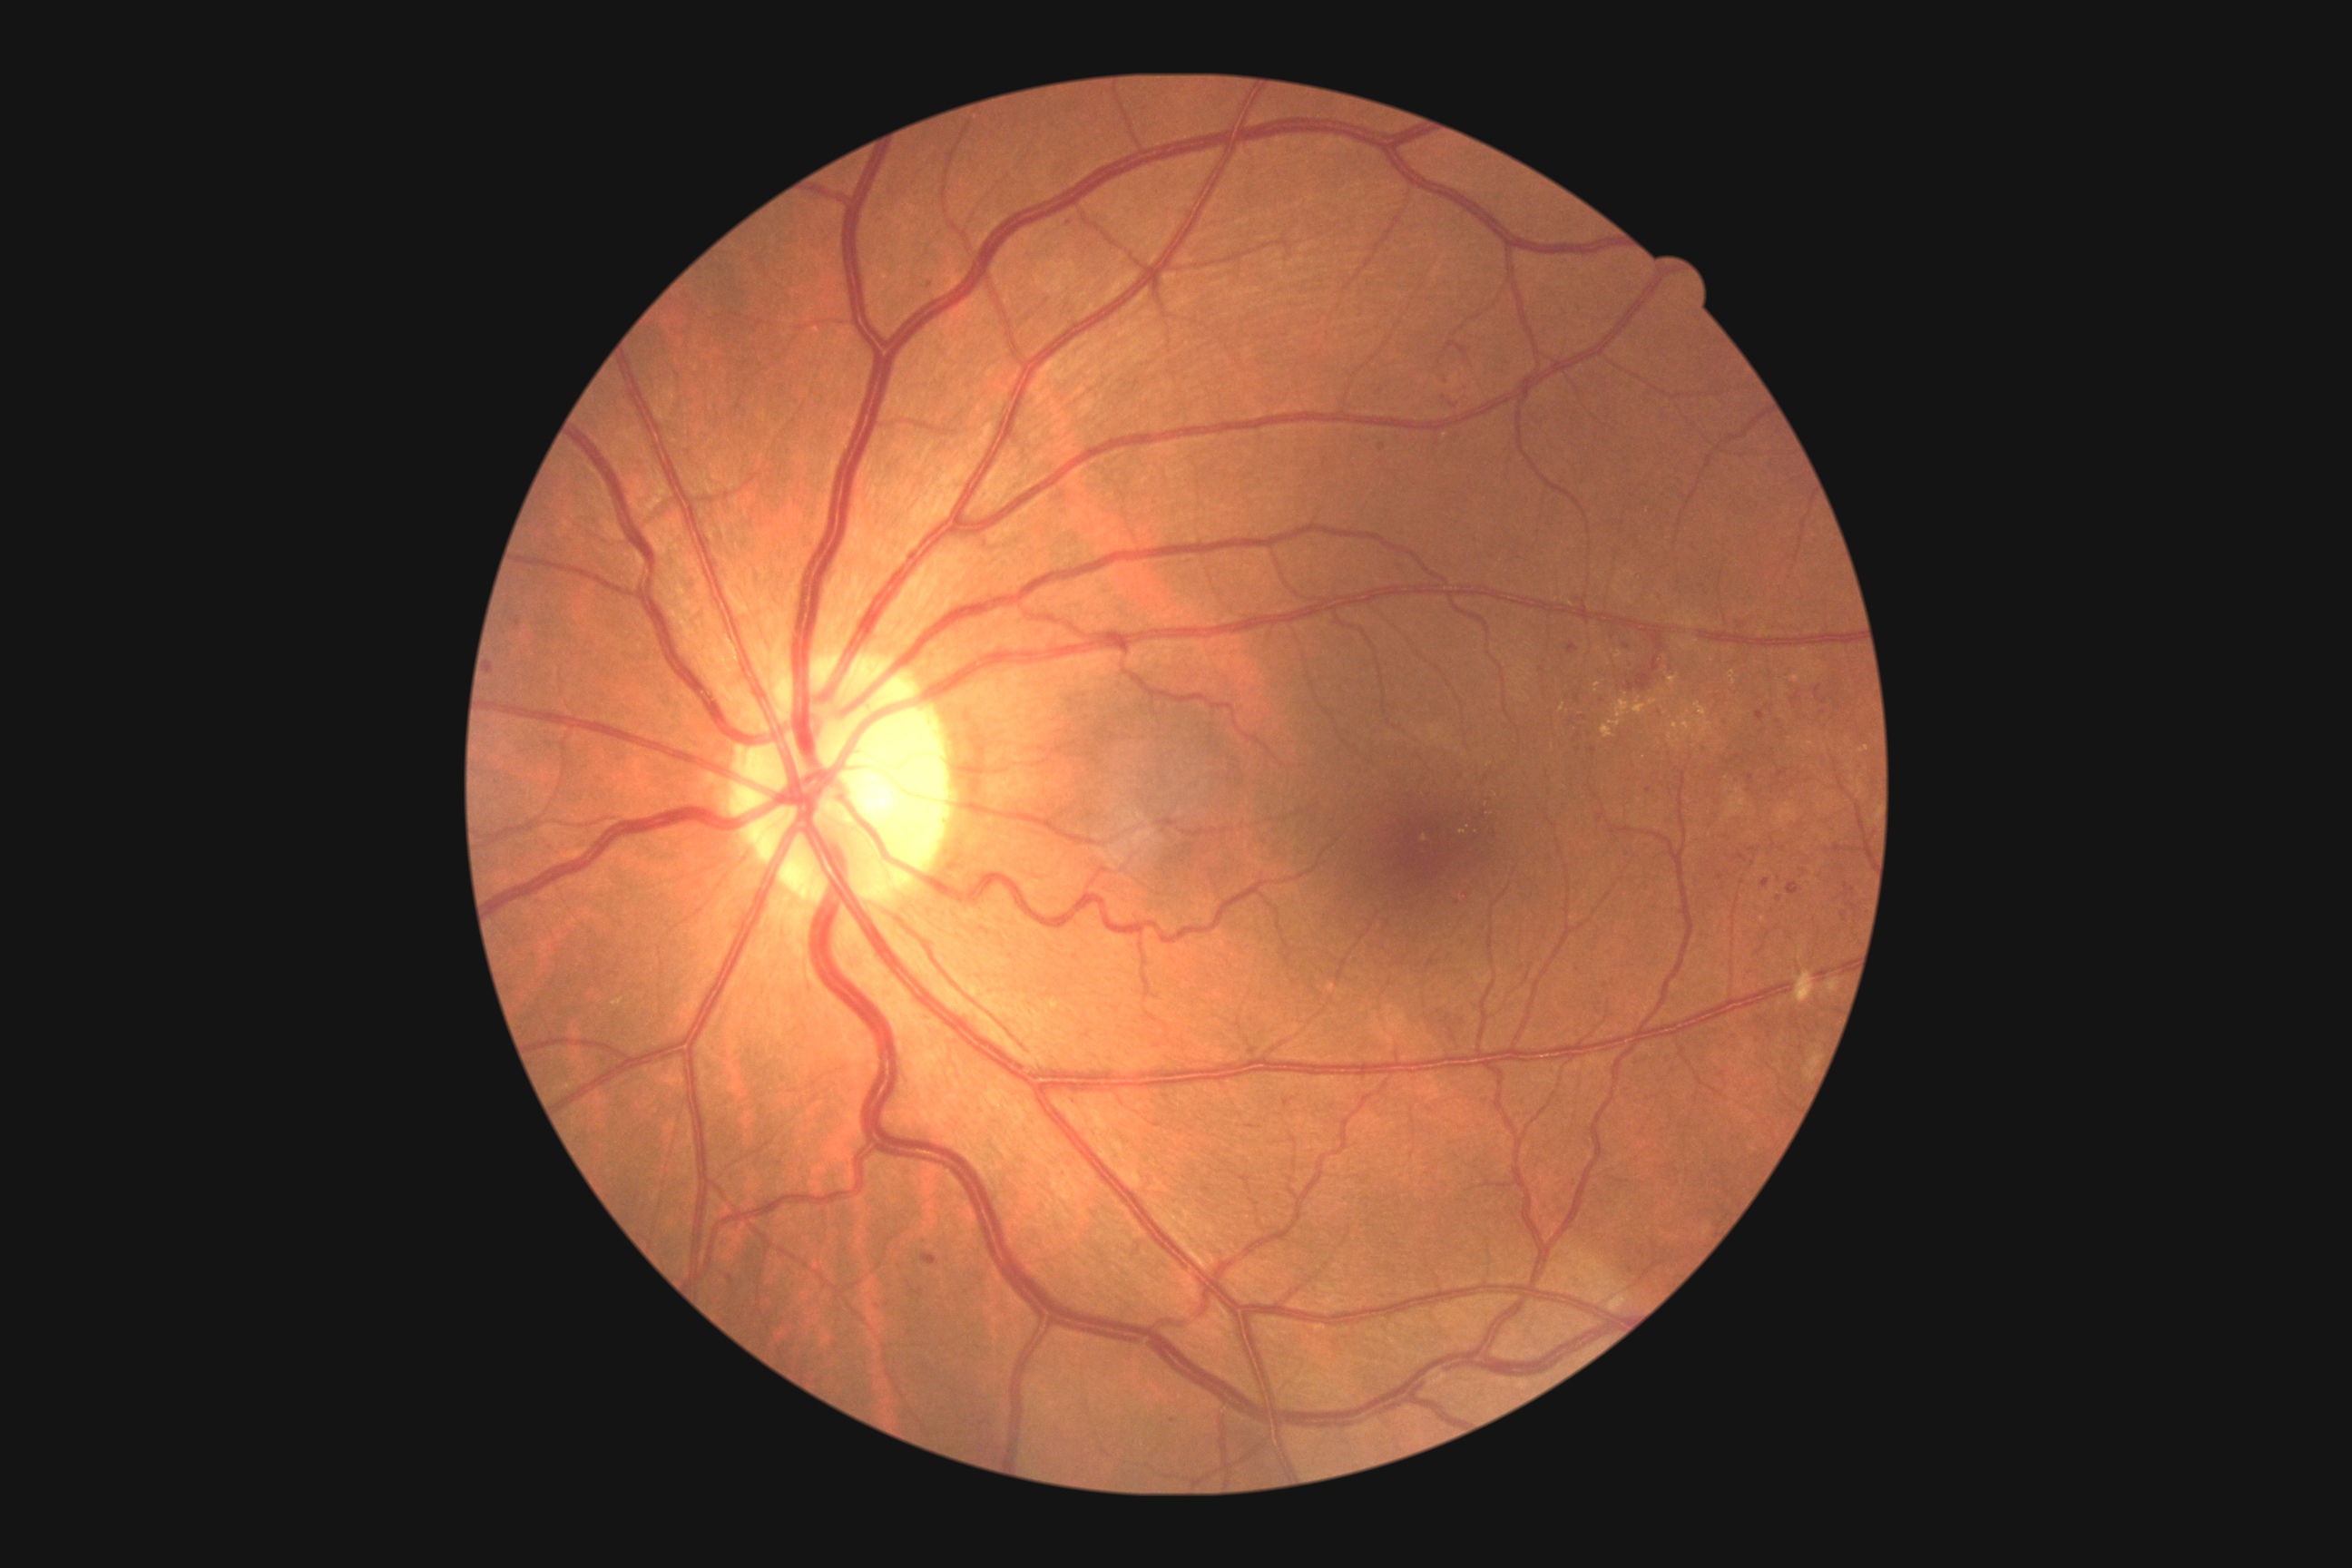
partial: true
dr_grade: 2
lesions:
  he:
    - [1446,340,1469,357]
    - [1758,946,1767,956]
    - [1736,854,1747,861]
    - [1816,685,1821,694]
    - [514,620,522,627]
    - [923,1255,937,1266]
    - [1756,710,1765,721]
    - [1569,1179,1580,1190]
    - [1440,377,1449,387]
    - [1600,696,1607,705]
  he_small_approx:
    - [1578, 699]
    - [1721, 876]
    - [1659, 714]
    - [1748, 792]
    - [1605, 985]
    - [1778, 900]